Diabetic retinopathy graded by the modified Davis classification · 45-degree field of view — 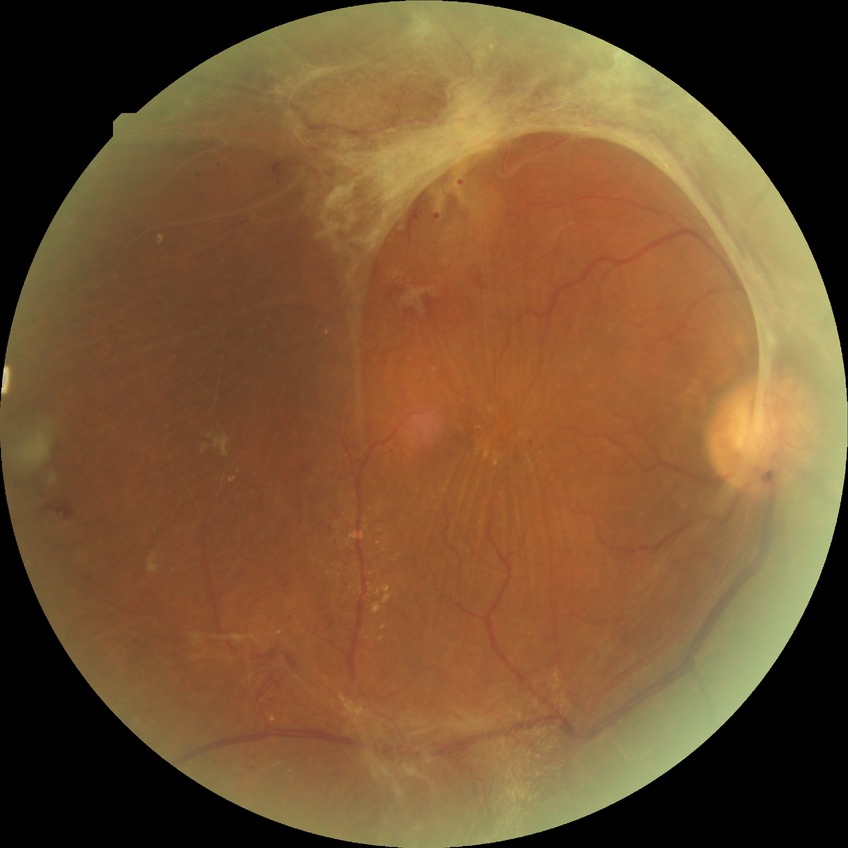
Davis stage: PDR.